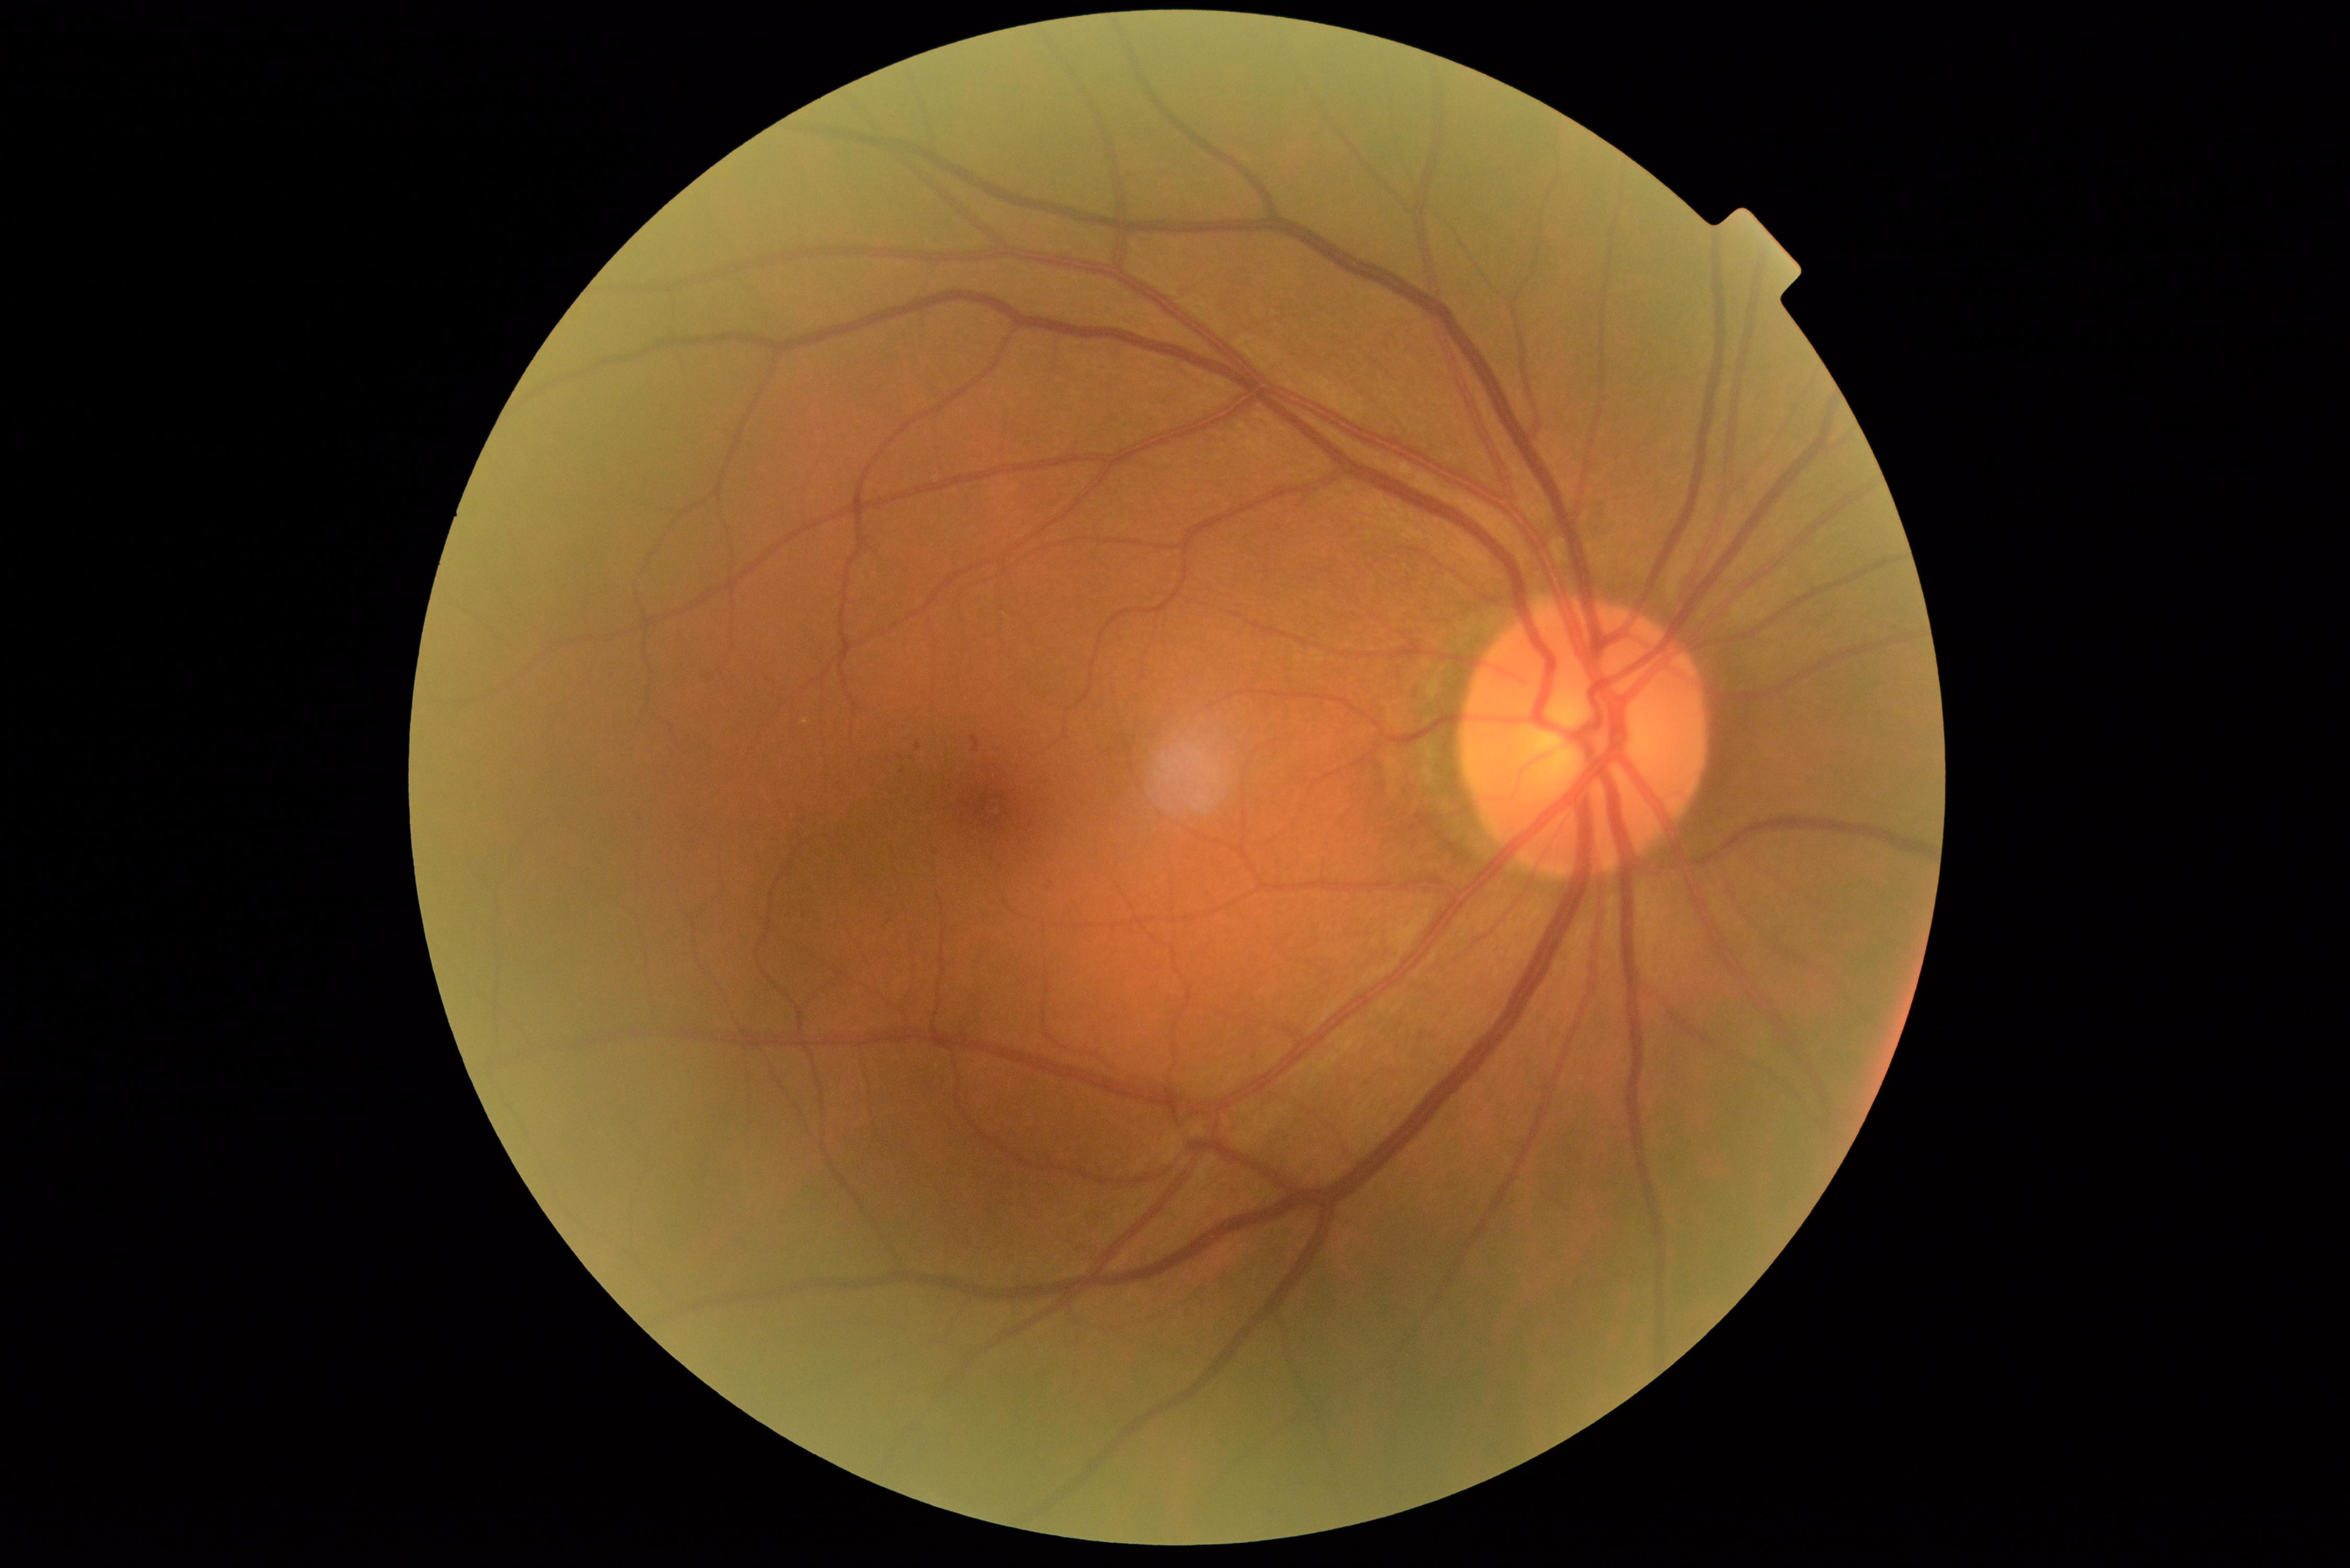

diabetic retinopathy grade: 1 (mild NPDR).